848x848, acquired with a NIDEK AFC-230:
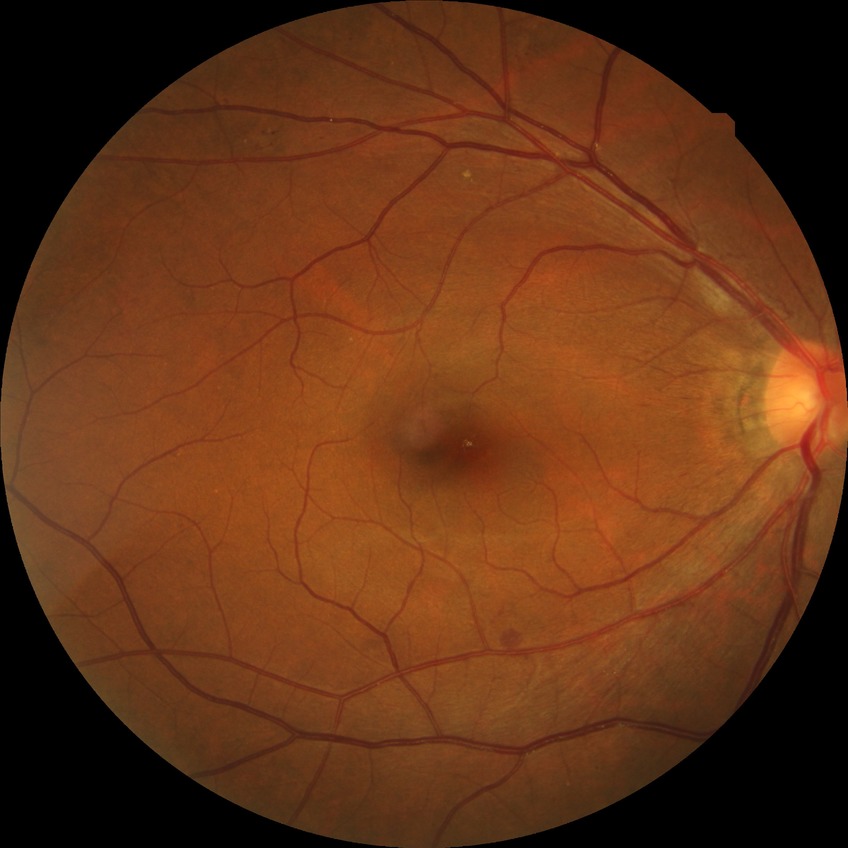
Diabetic retinopathy grade is simple diabetic retinopathy. DR class: non-proliferative diabetic retinopathy.